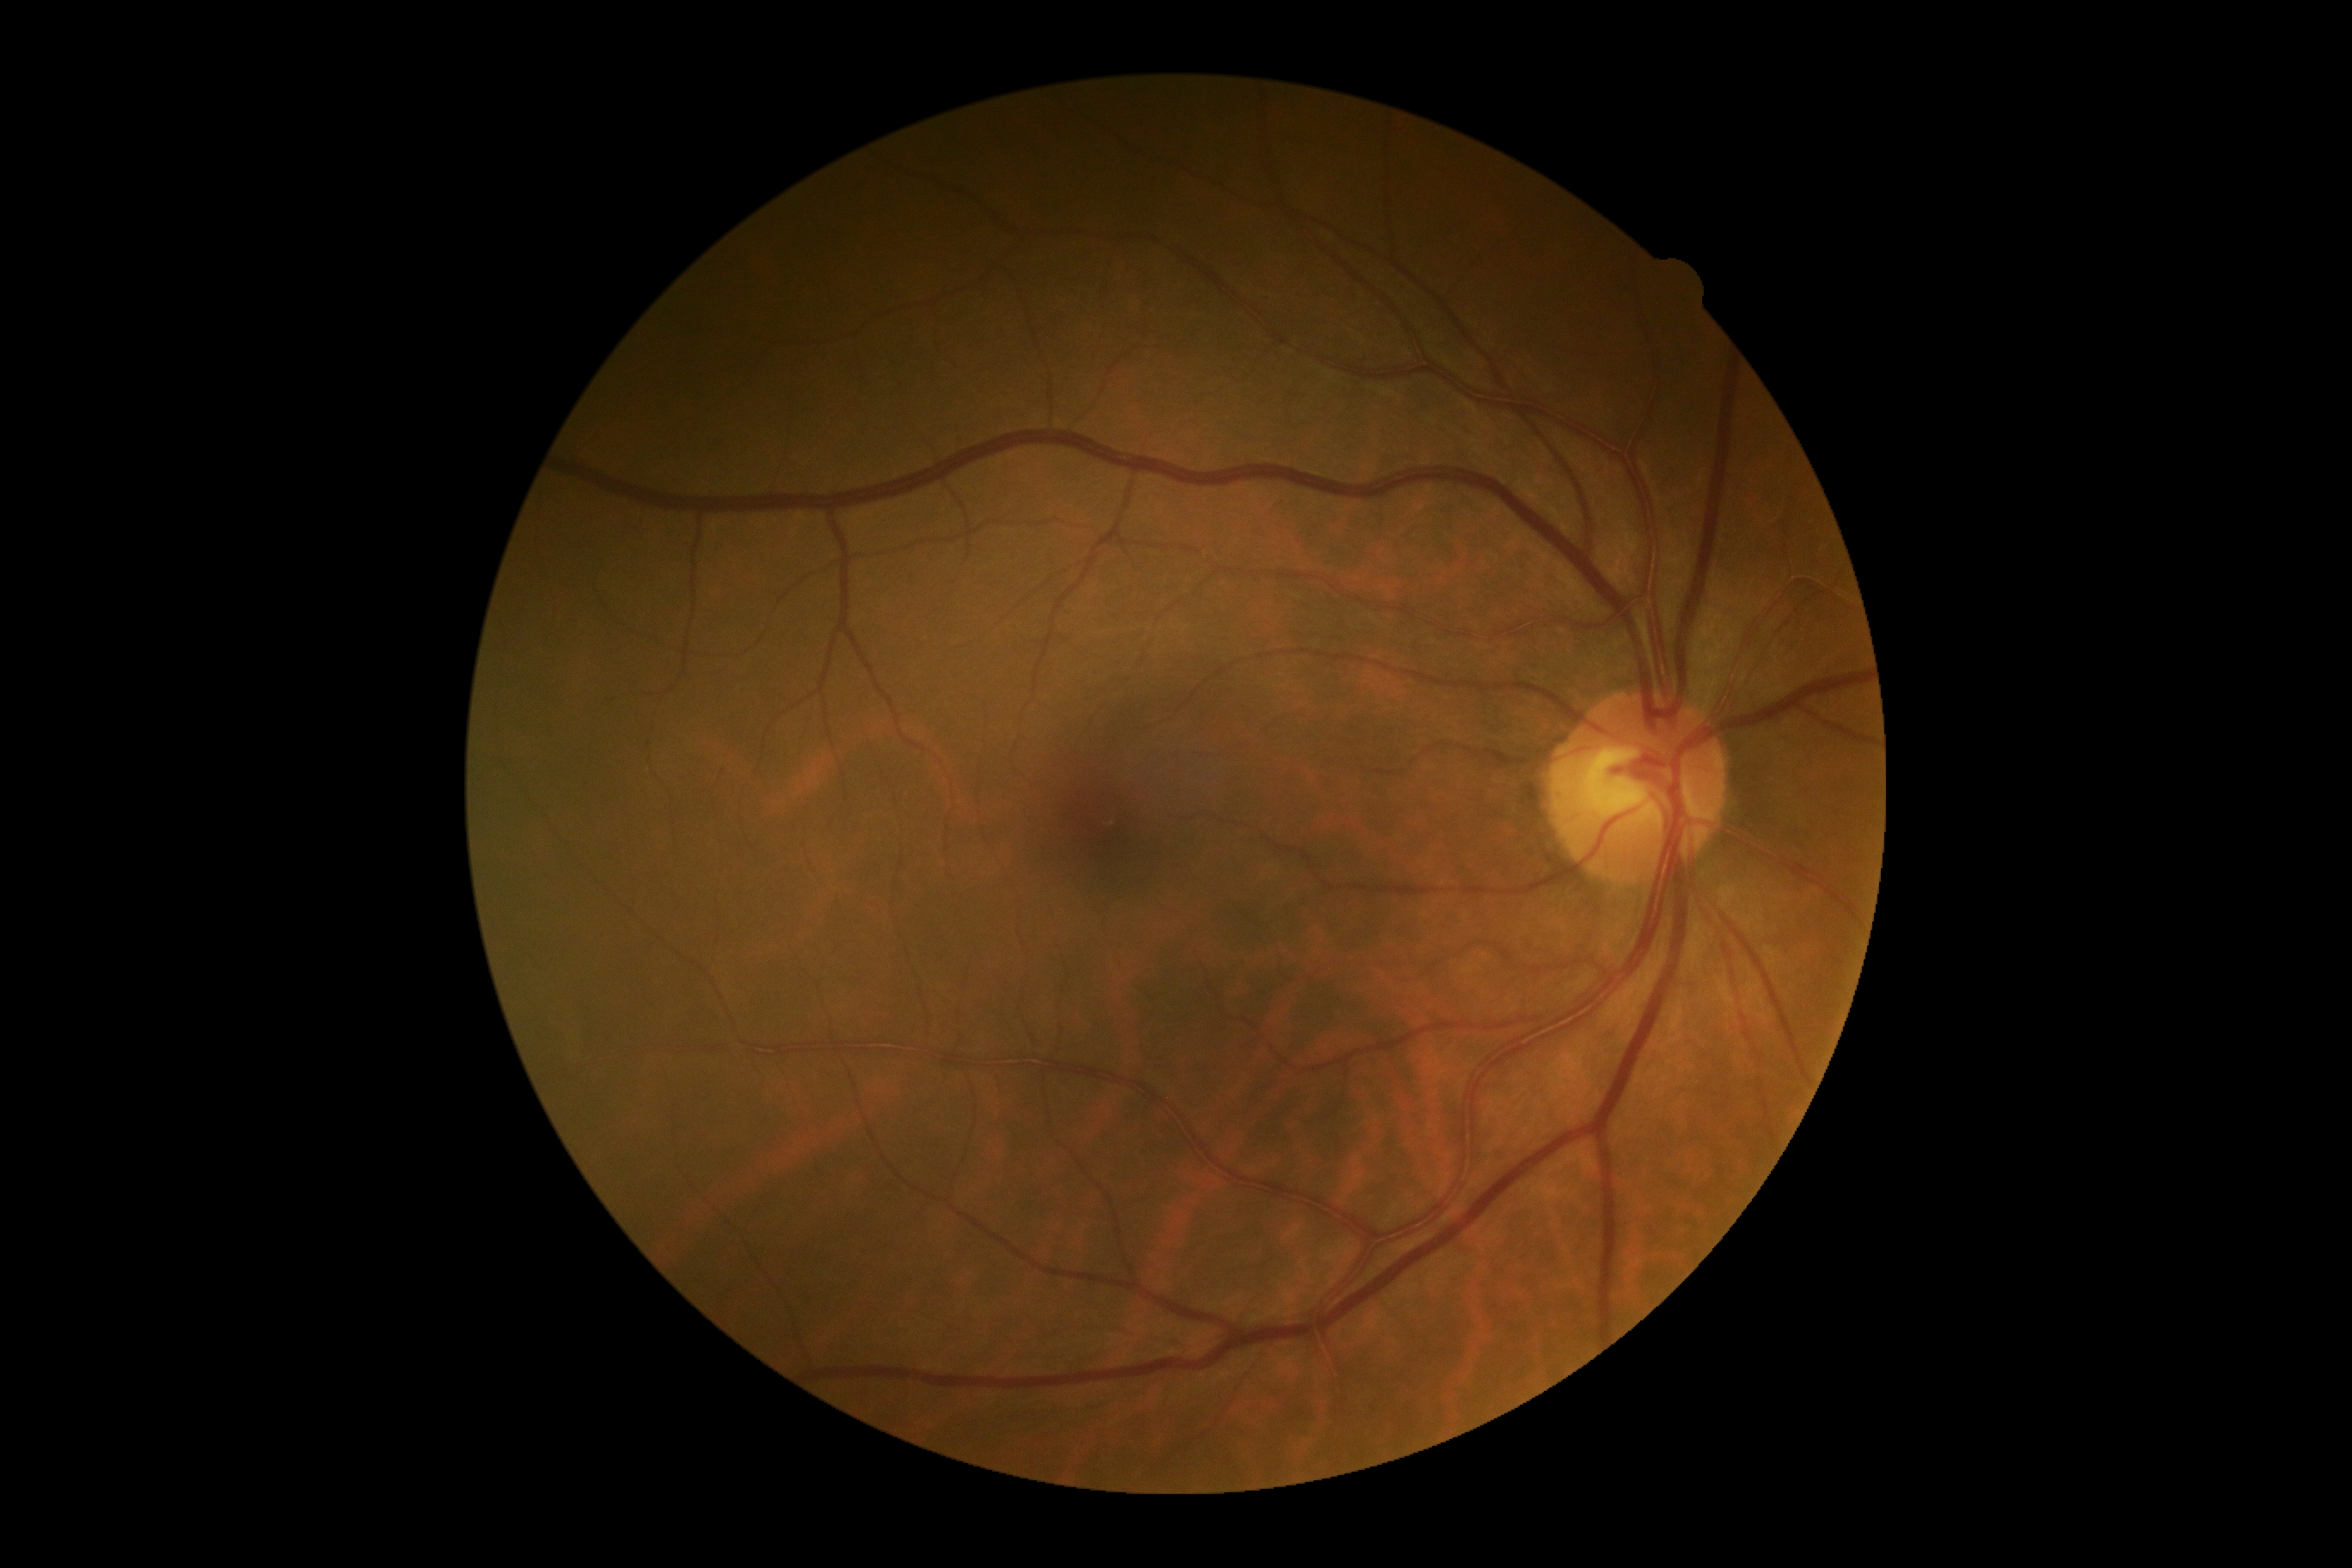
DR is grade 0 (no apparent retinopathy).